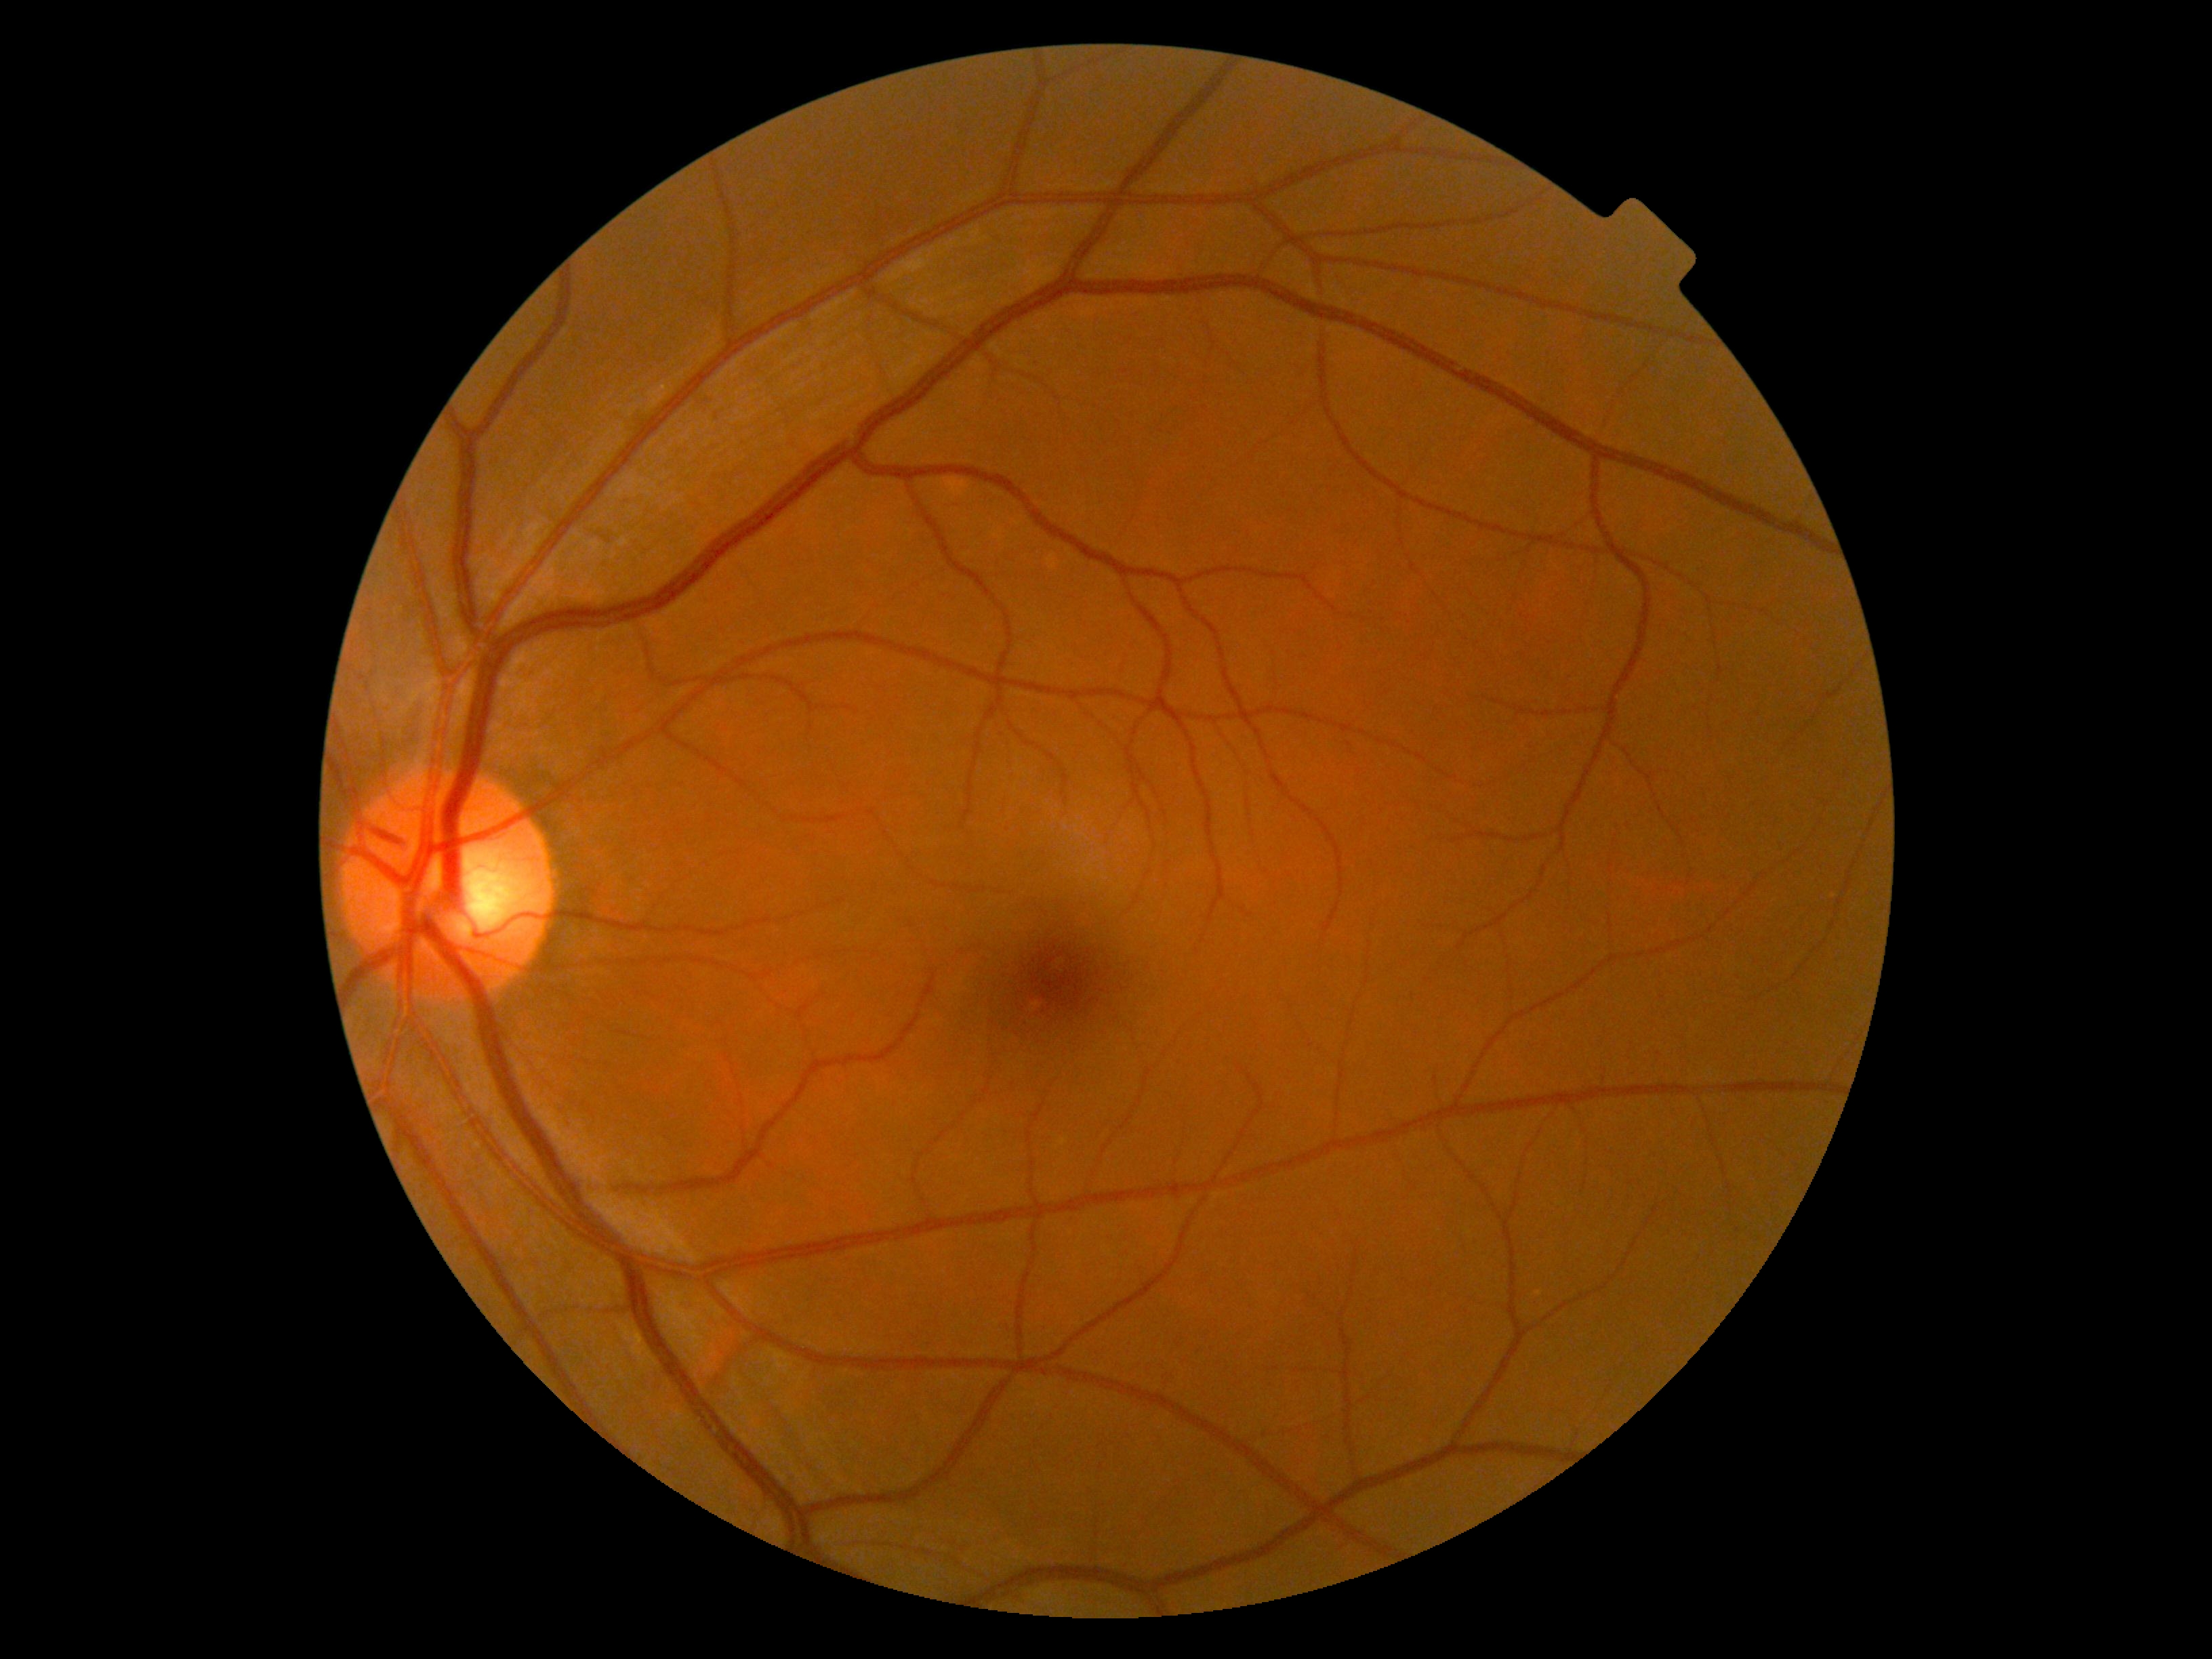

{
  "dr_grade": "grade 0 (no apparent retinopathy)",
  "dr_impression": "negative for DR"
}